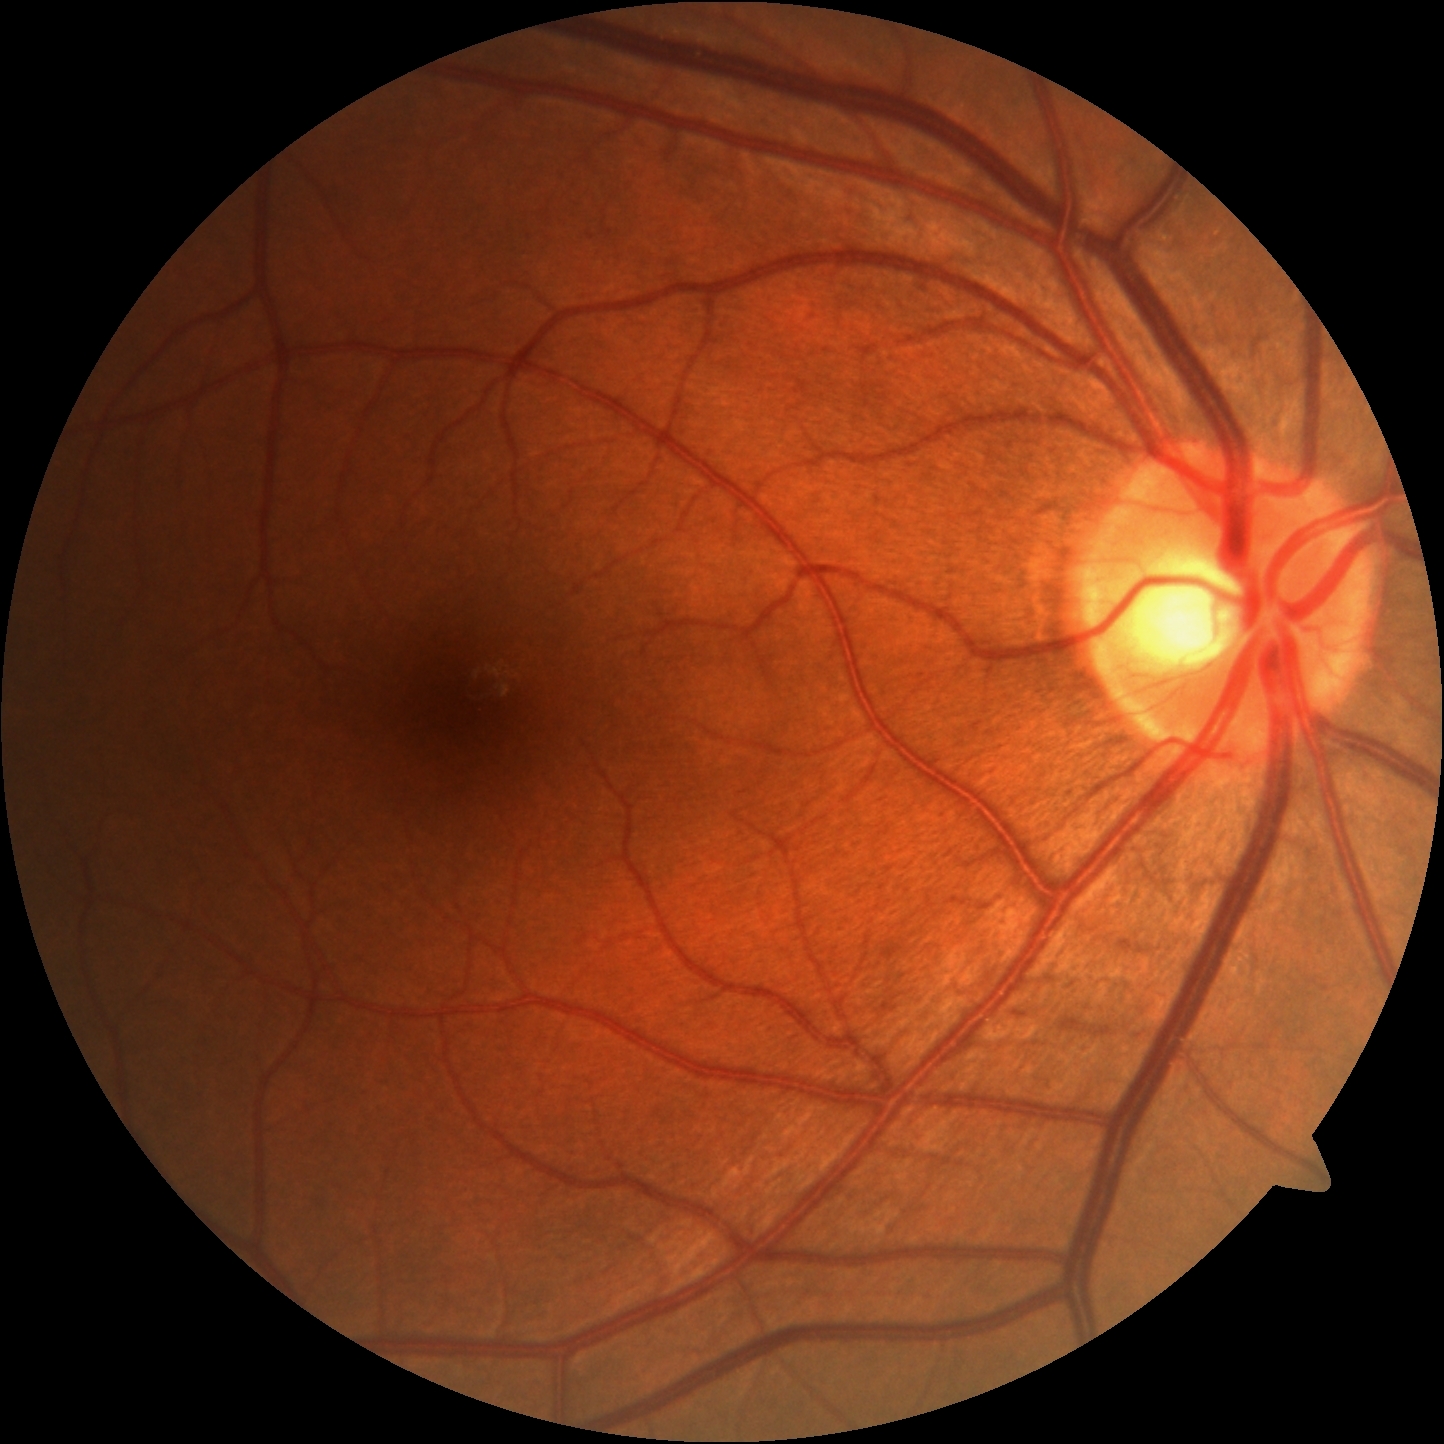

  dr_impression: no signs of DR
  dr_grade: grade 0 (no apparent retinopathy) — no visible signs of diabetic retinopathy